1240x1240; infant wide-field retinal image; camera: Phoenix ICON (100° FOV):
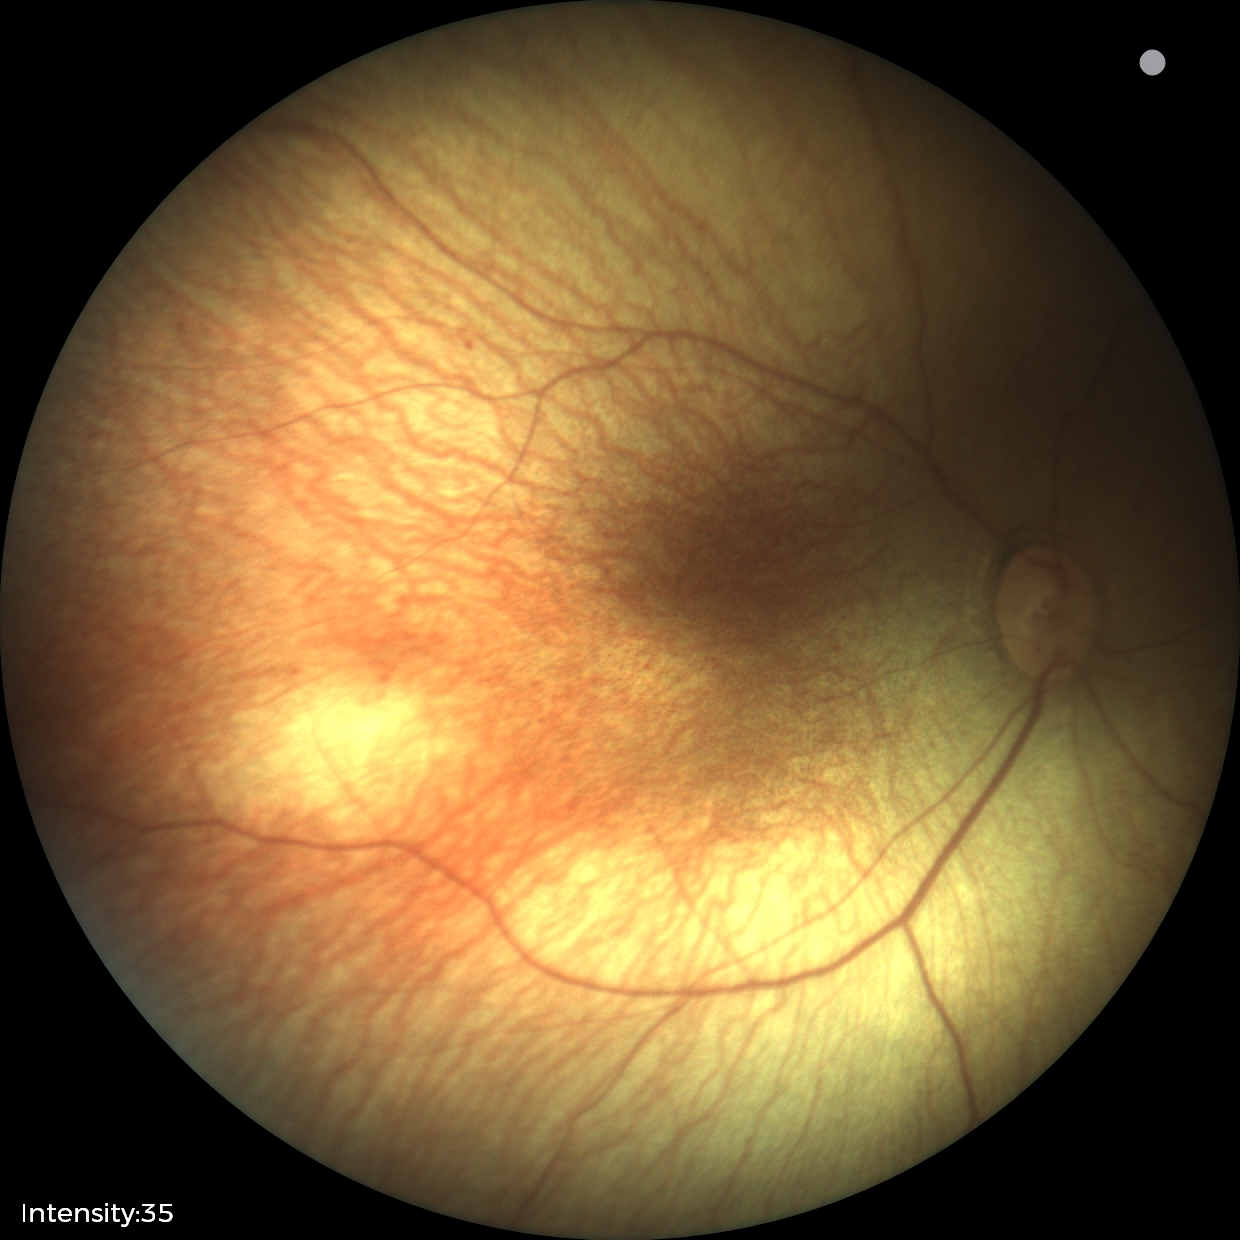

Finding = no abnormalities.